45° FOV; color fundus photograph; 2212 by 1659 pixels: 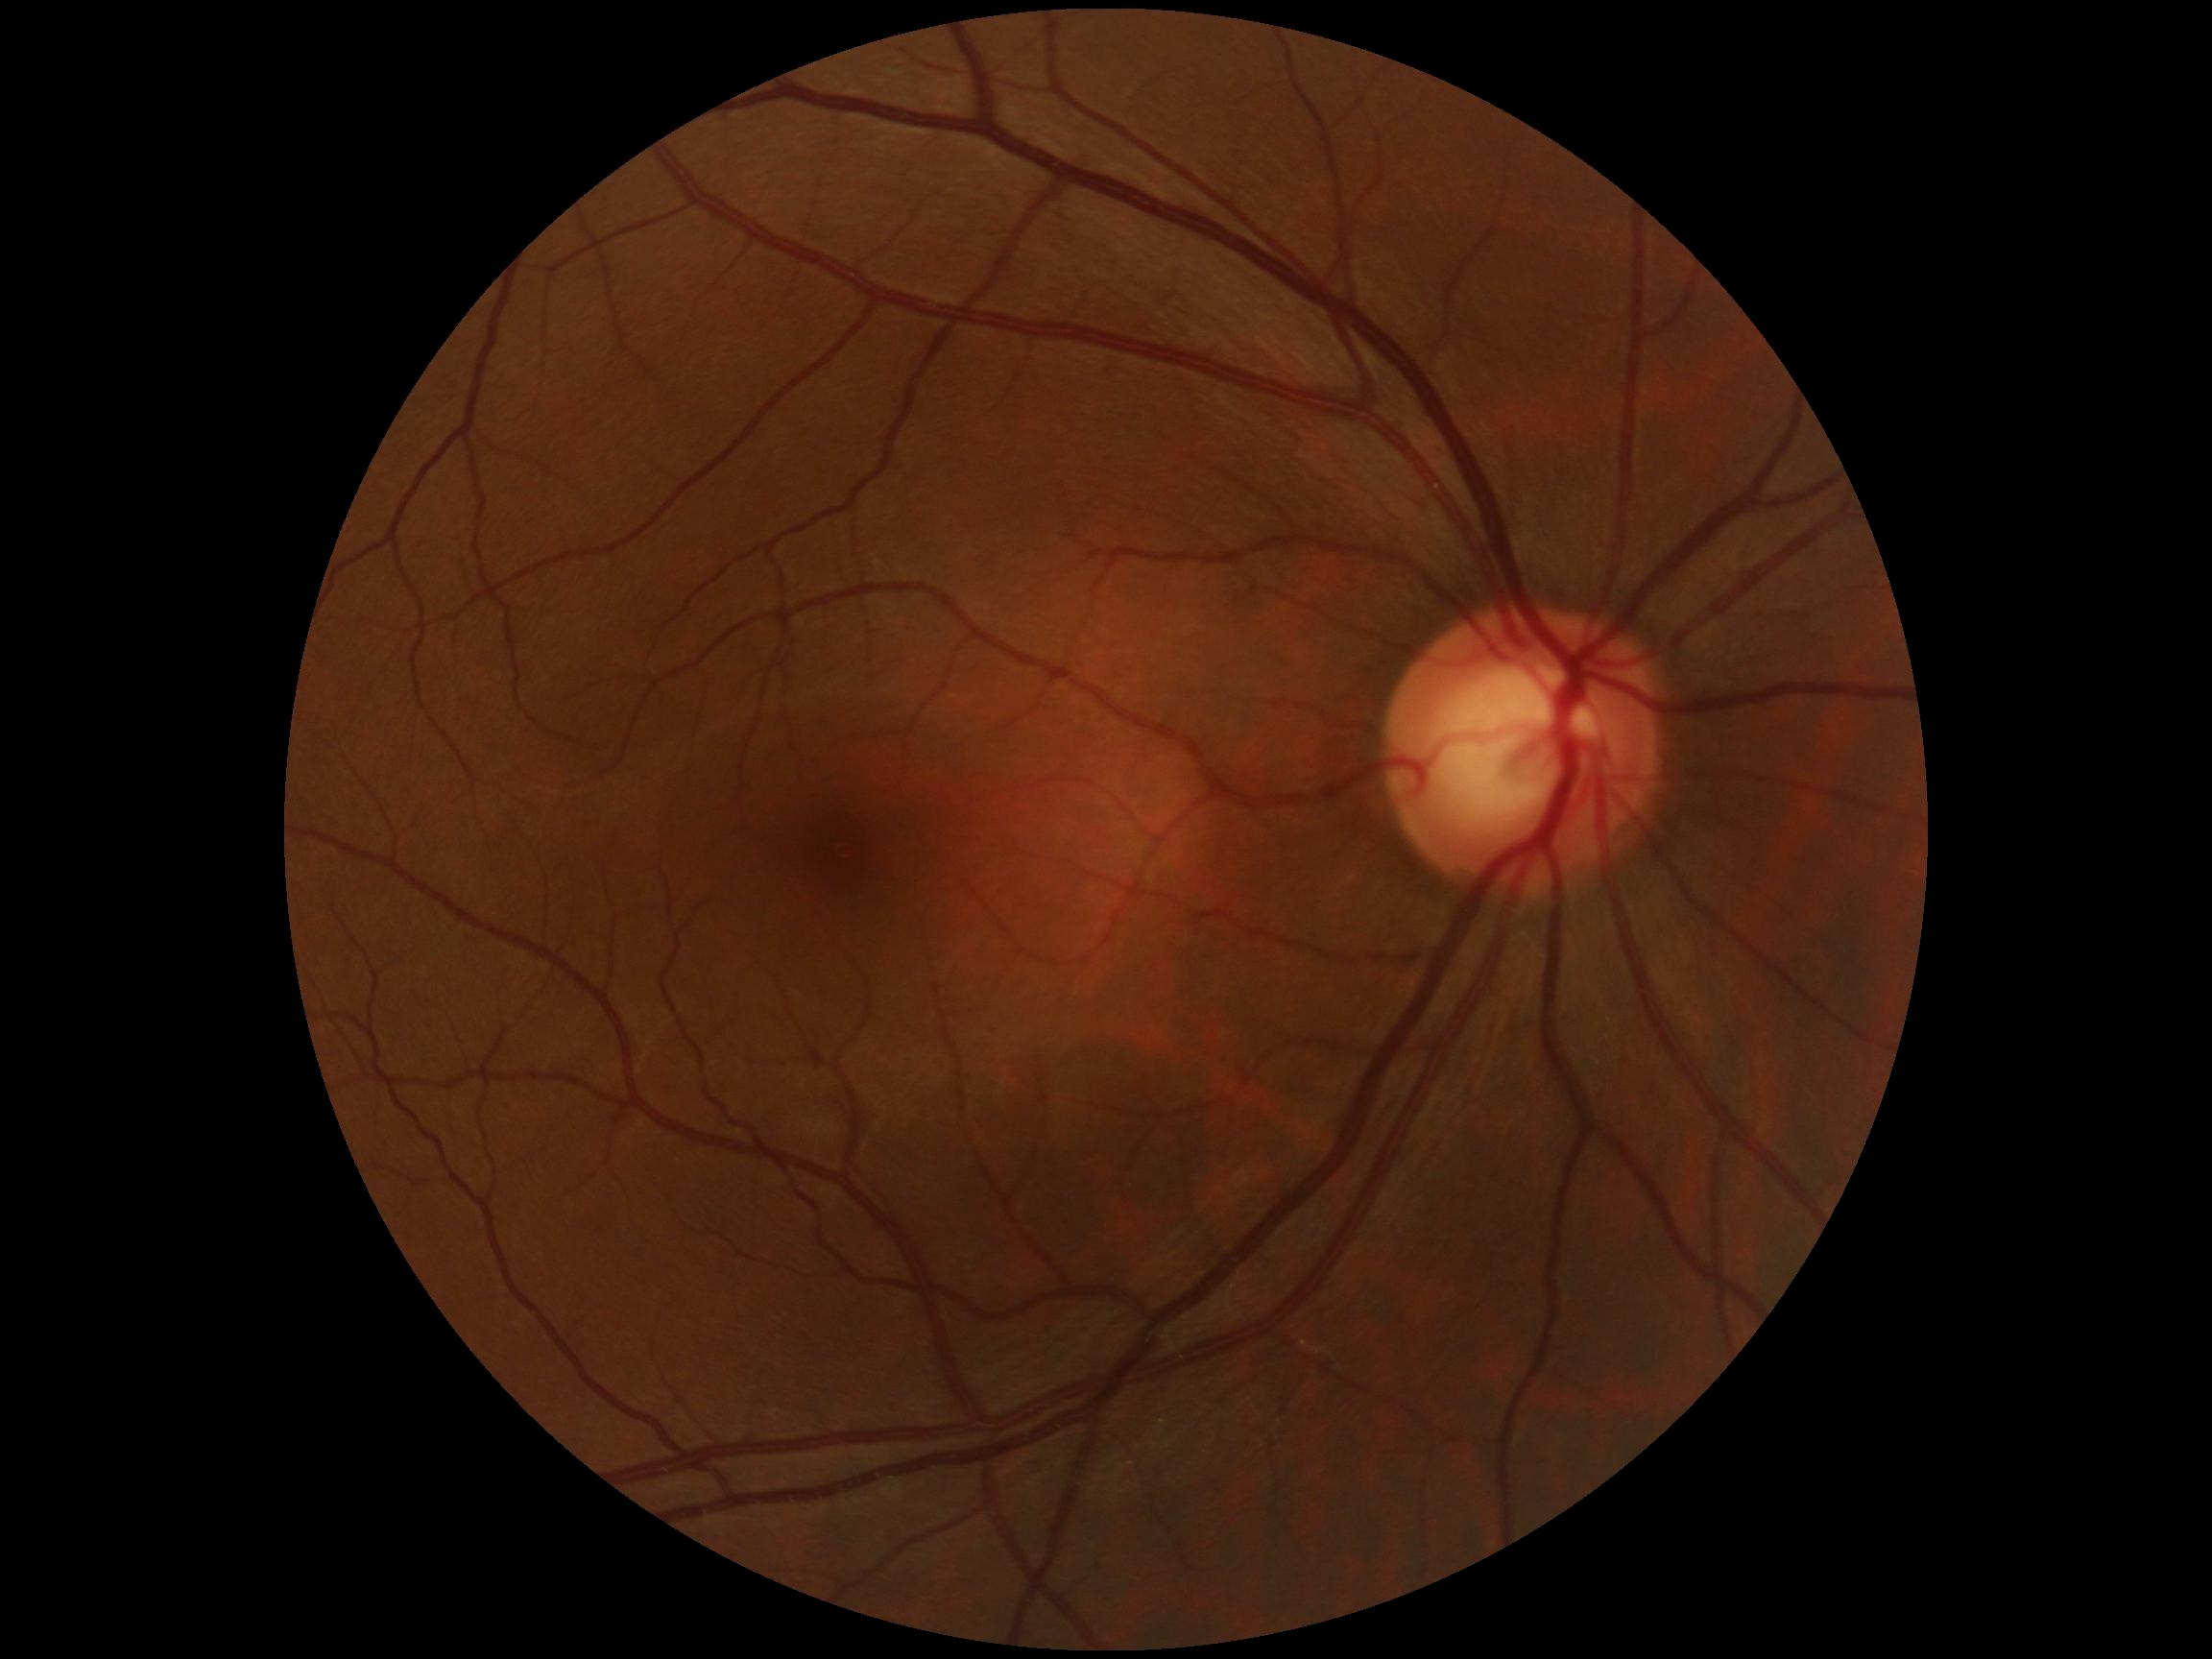
retinopathy: grade 0 — no visible signs of diabetic retinopathy.